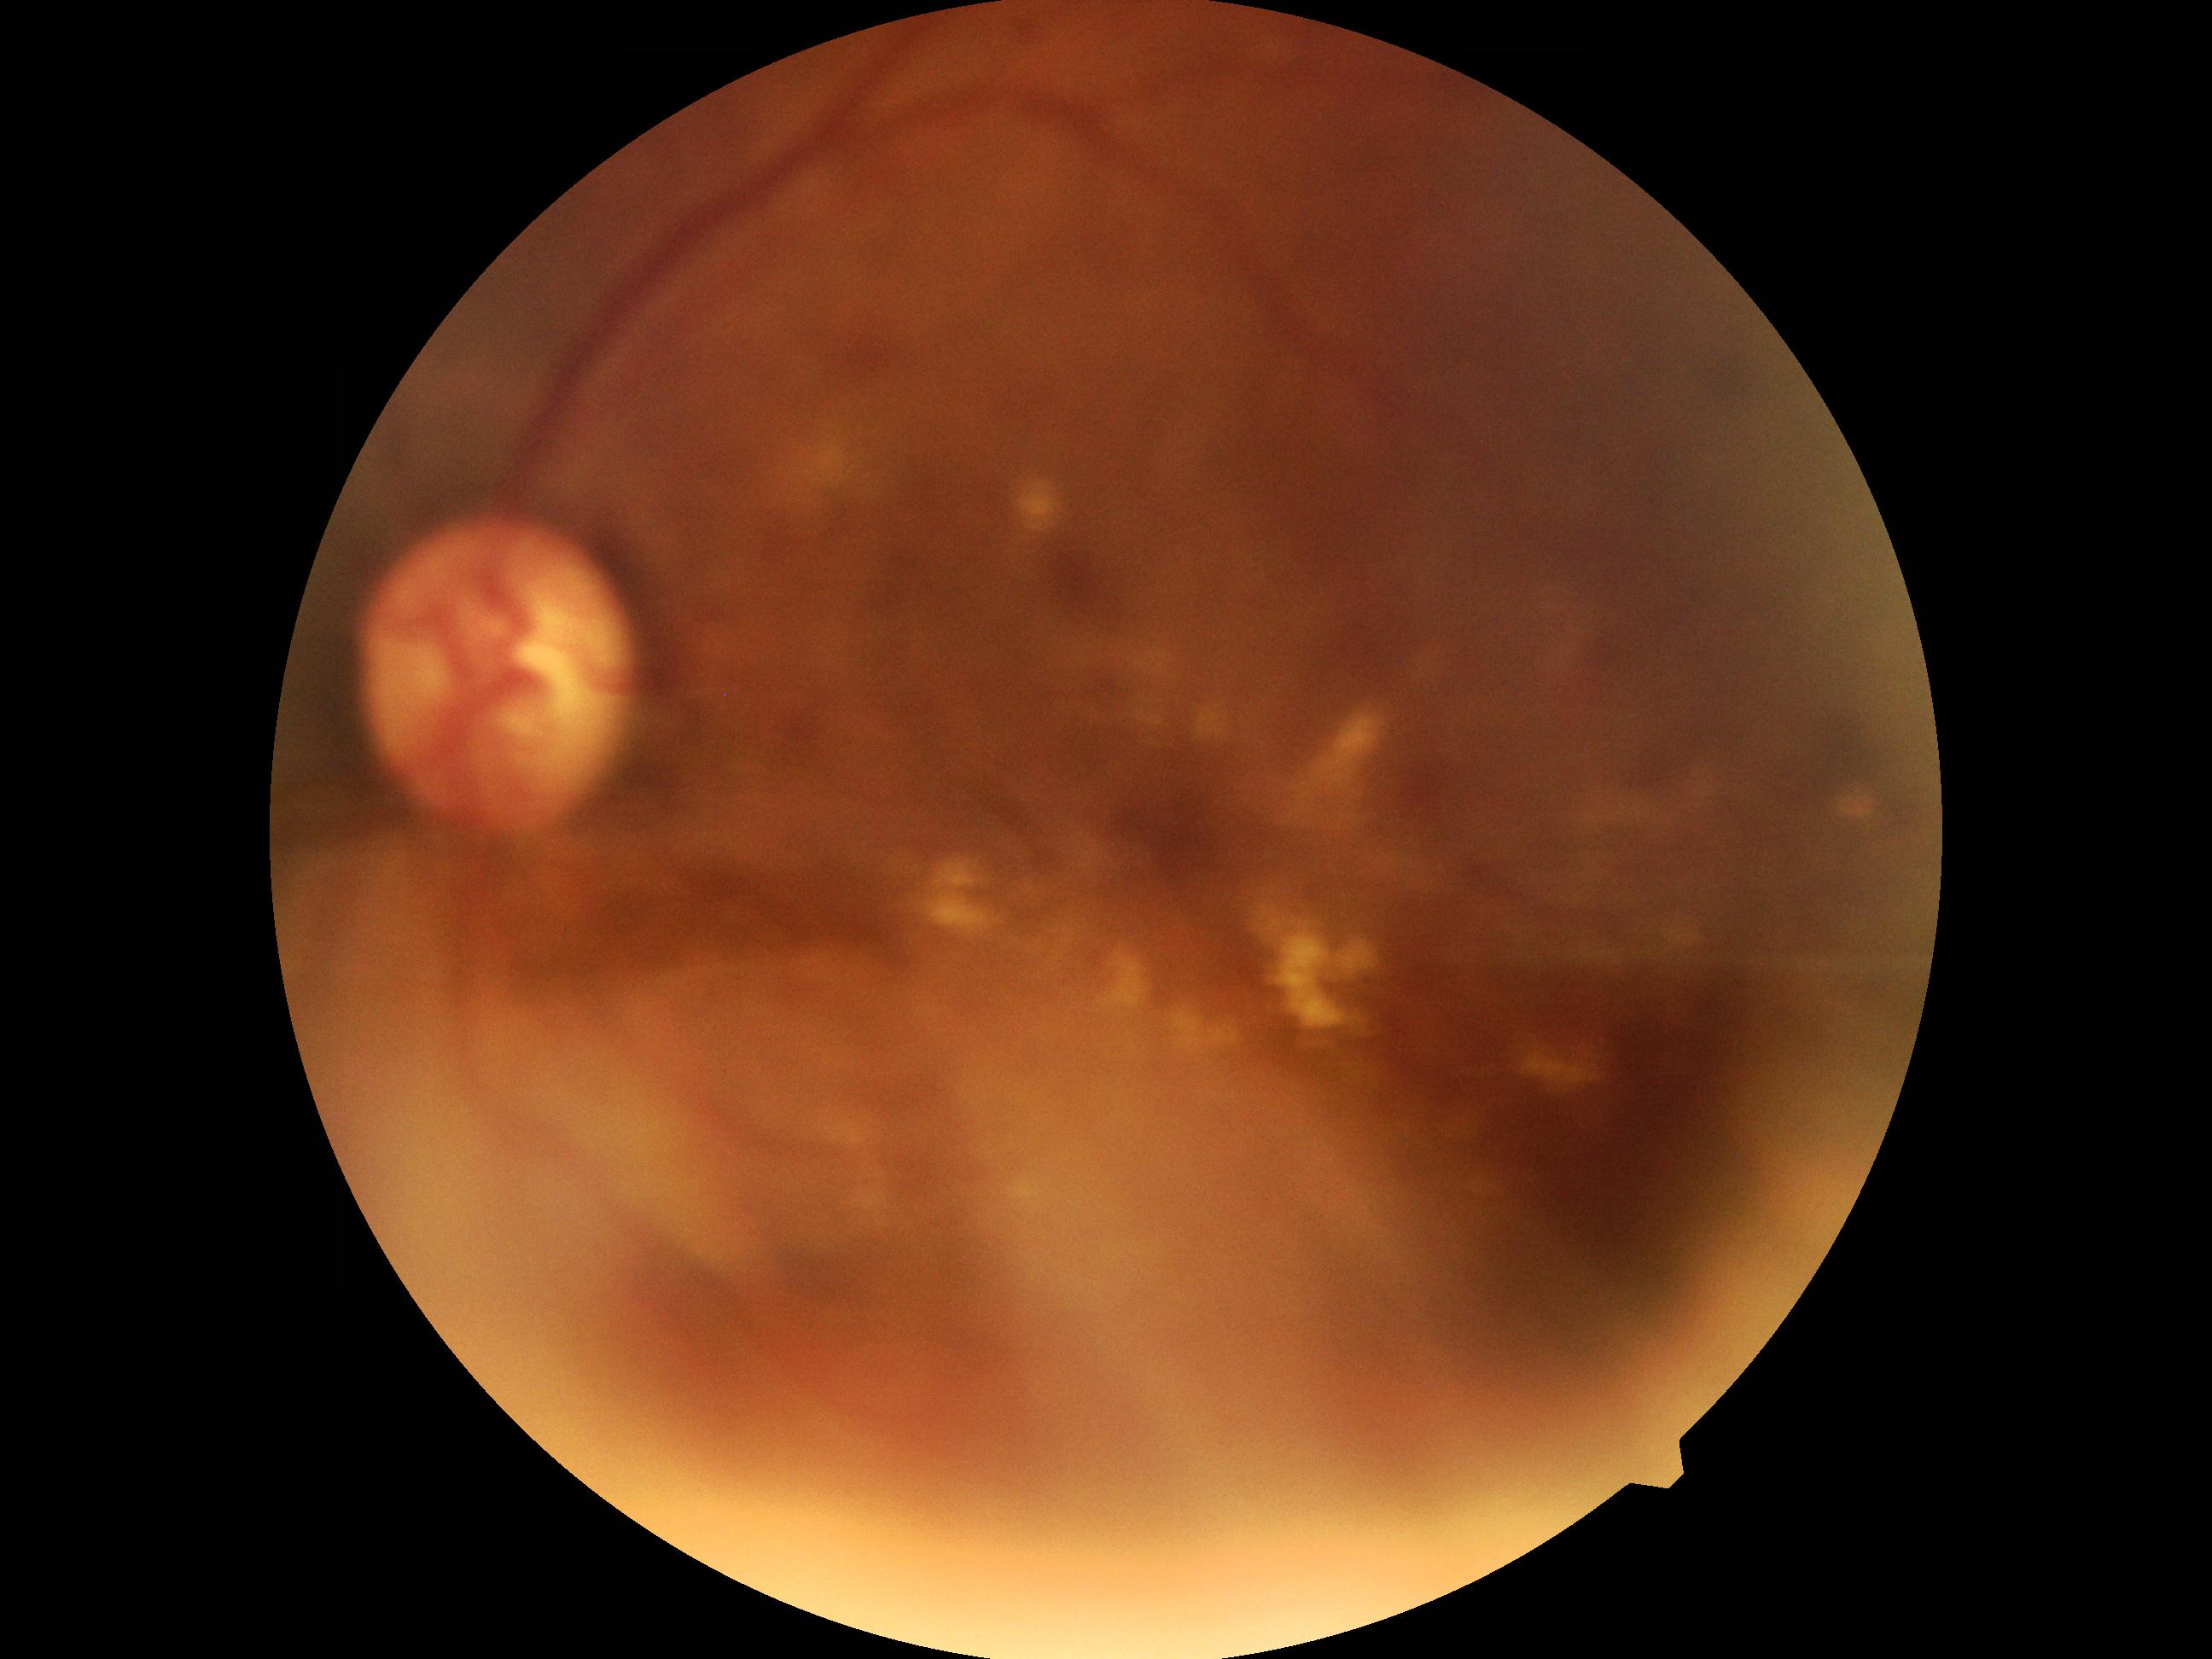

Diabetic retinopathy severity: moderate non-proliferative diabetic retinopathy (grade 2).